1659x2212px
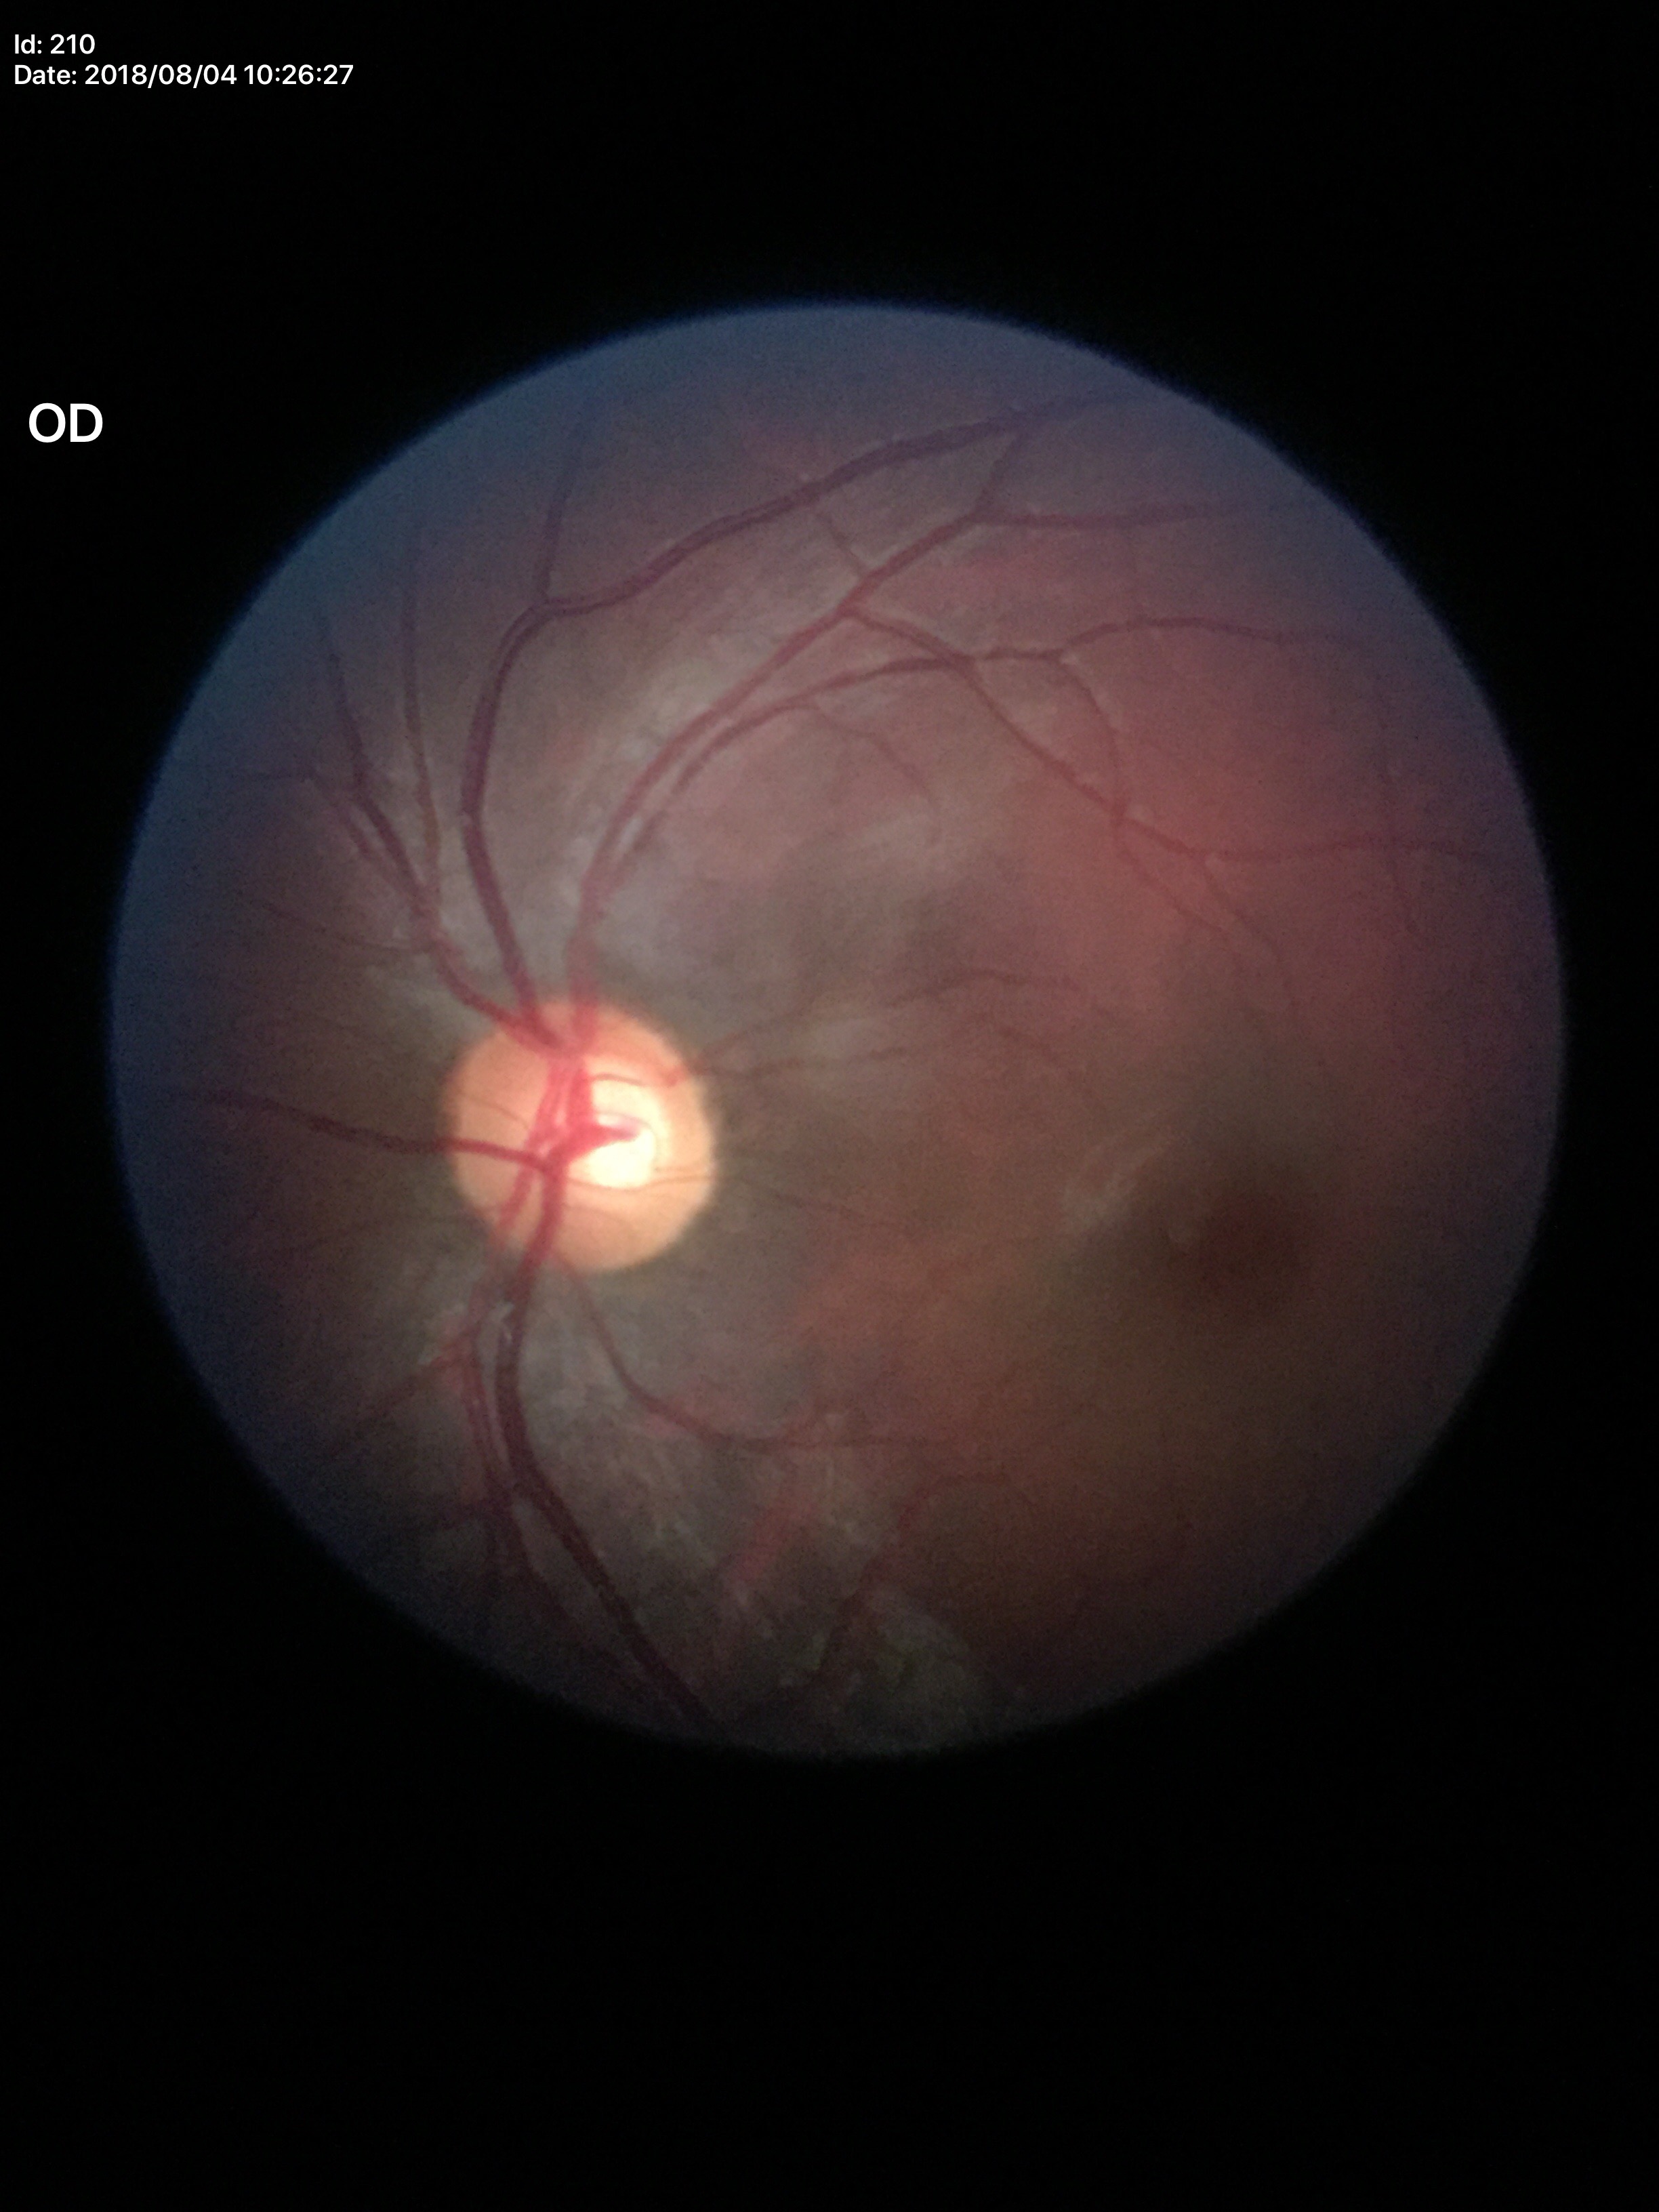 No glaucomatous optic neuropathy.
Vertical cup-disc ratio is 0.53.
Area cup-to-disc ratio is 0.33.
Horizontal CDR is 0.61.